1932 x 1932 pixels
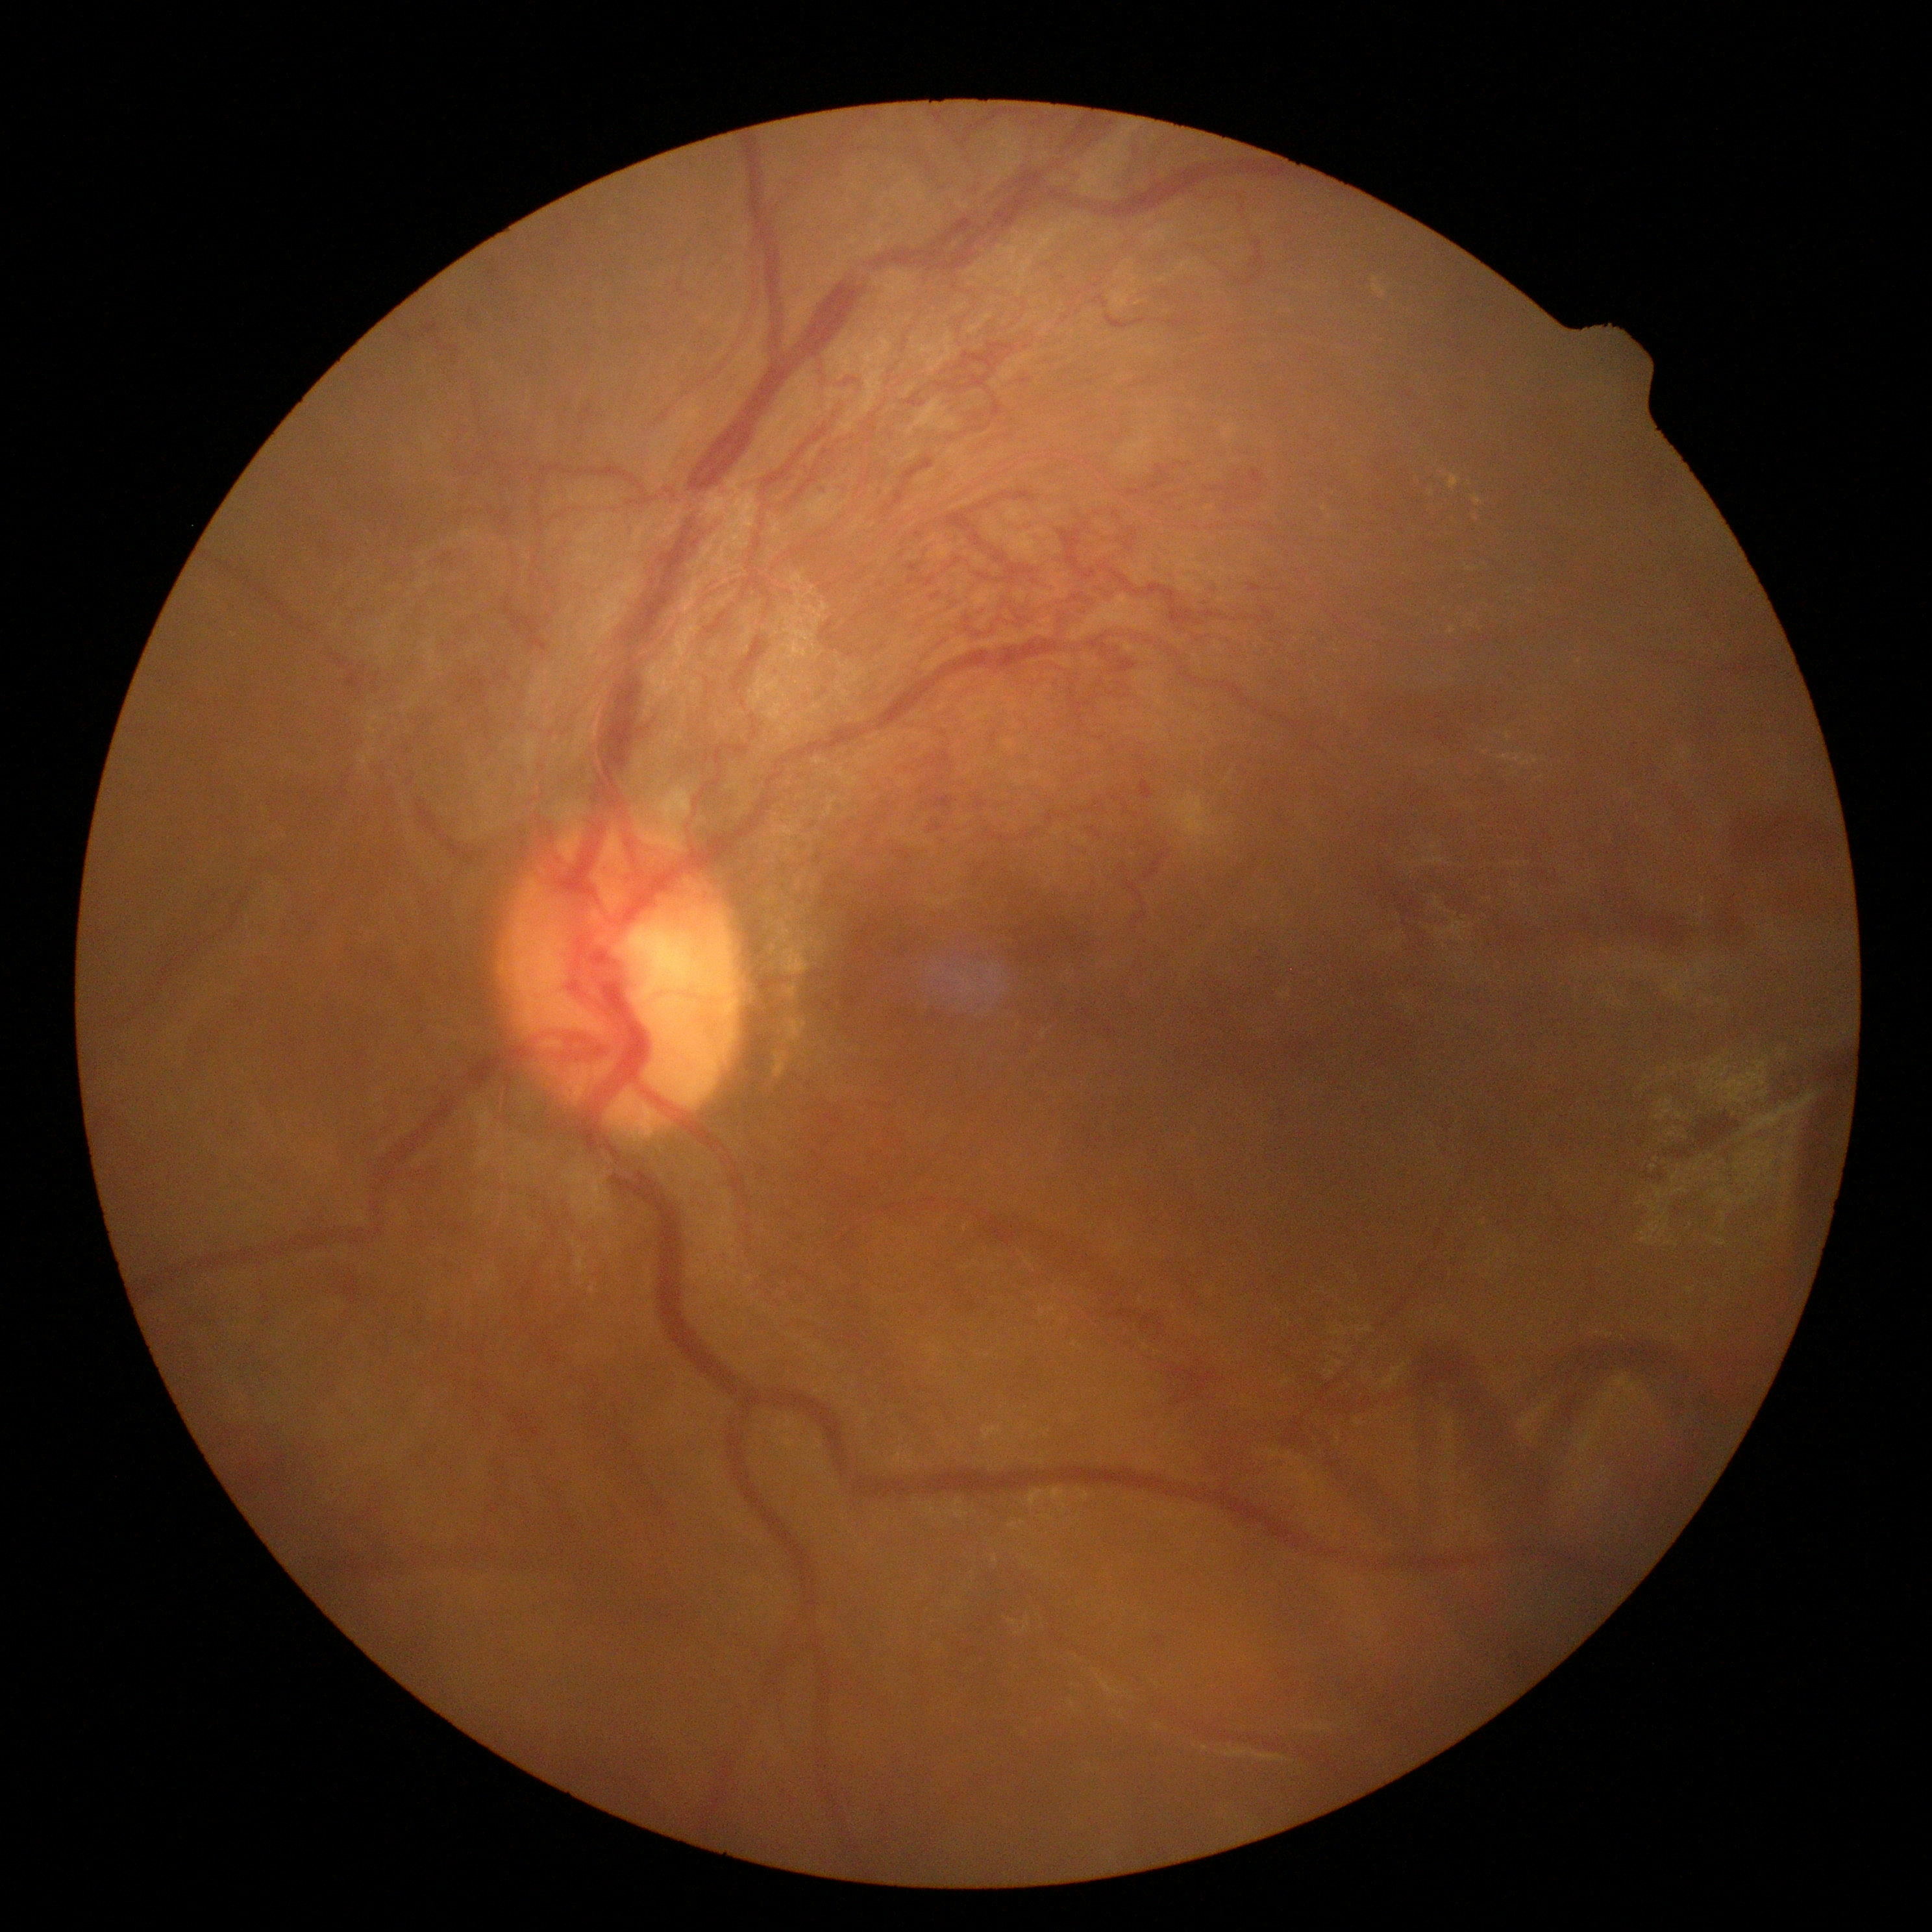
Diabetic retinopathy (DR): proliferative diabetic retinopathy (grade 4) — neovascularization and/or vitreous/pre-retinal hemorrhage.